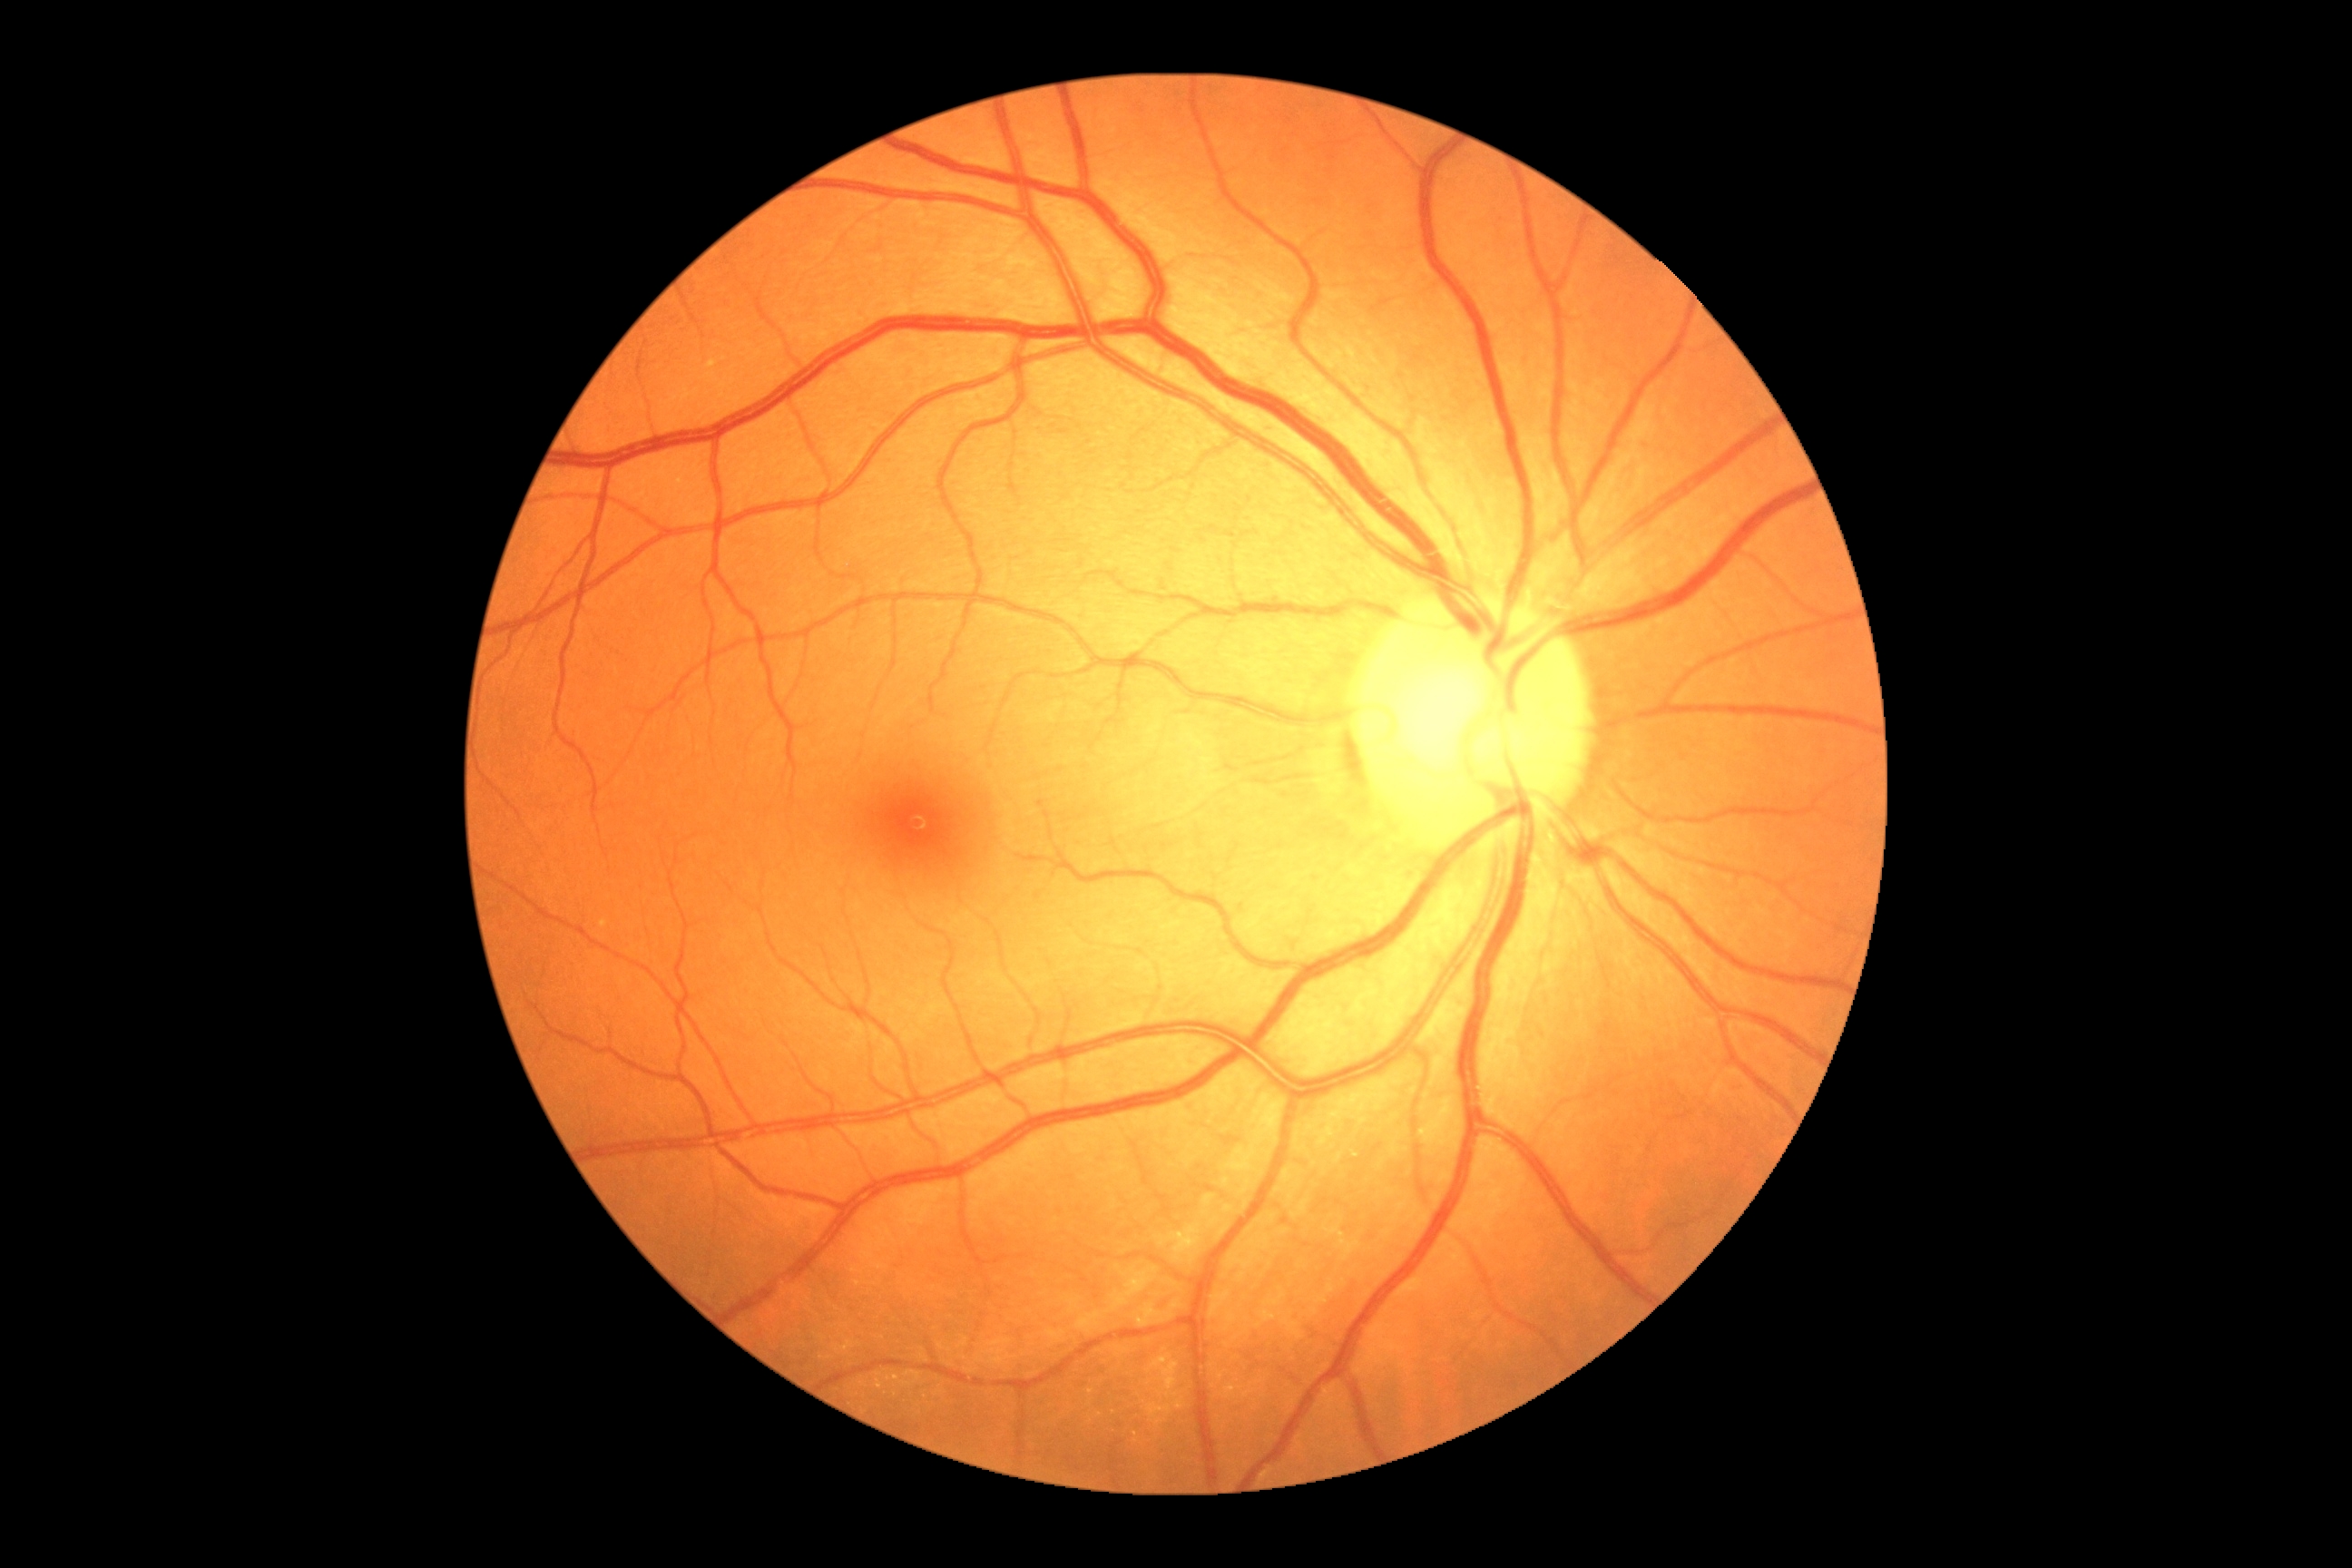
{"dr_impression": "no apparent DR", "dr_grade": "no apparent diabetic retinopathy (grade 0)"}